Modified Davis classification: 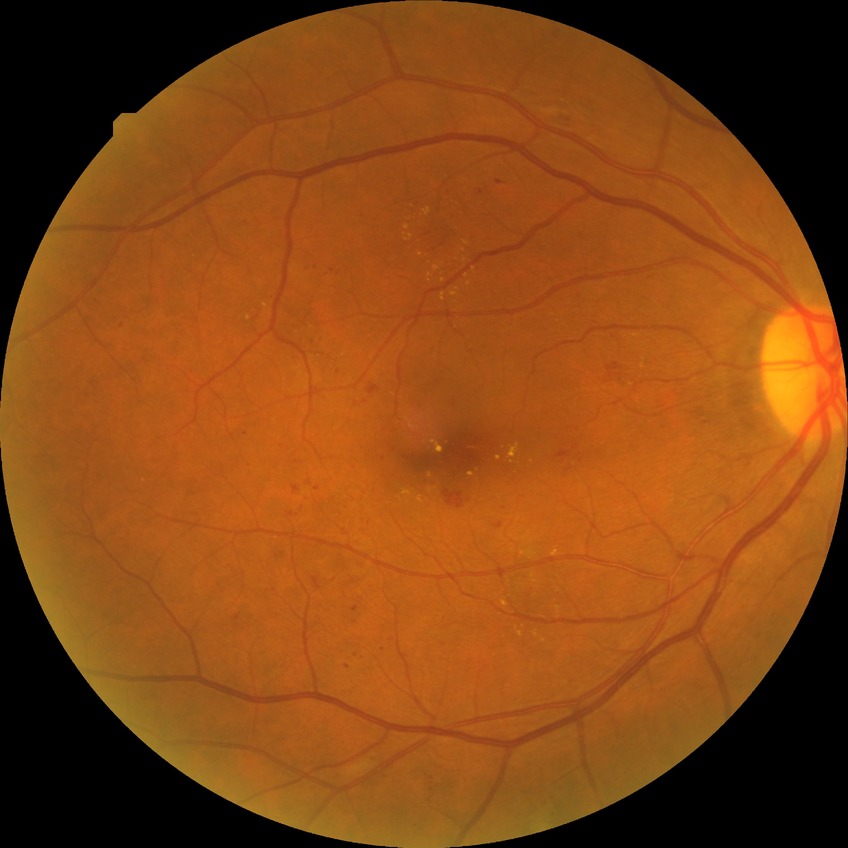
Davis stage is PPDR.